Image size 848x848:
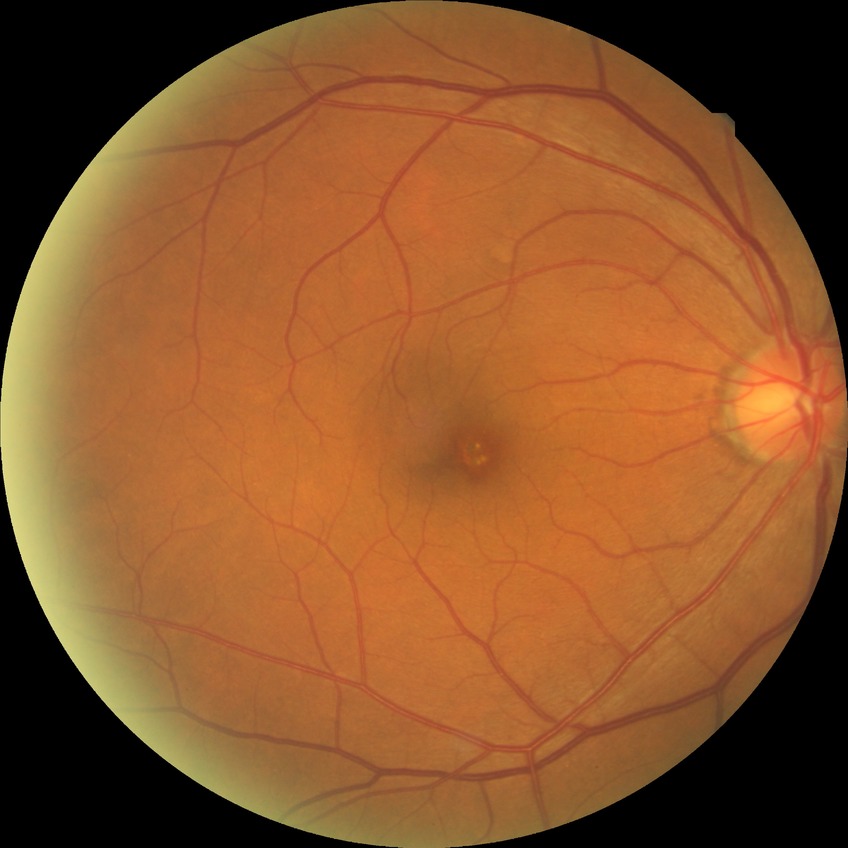 DR severity is NDR.